Infant wide-field fundus photograph:
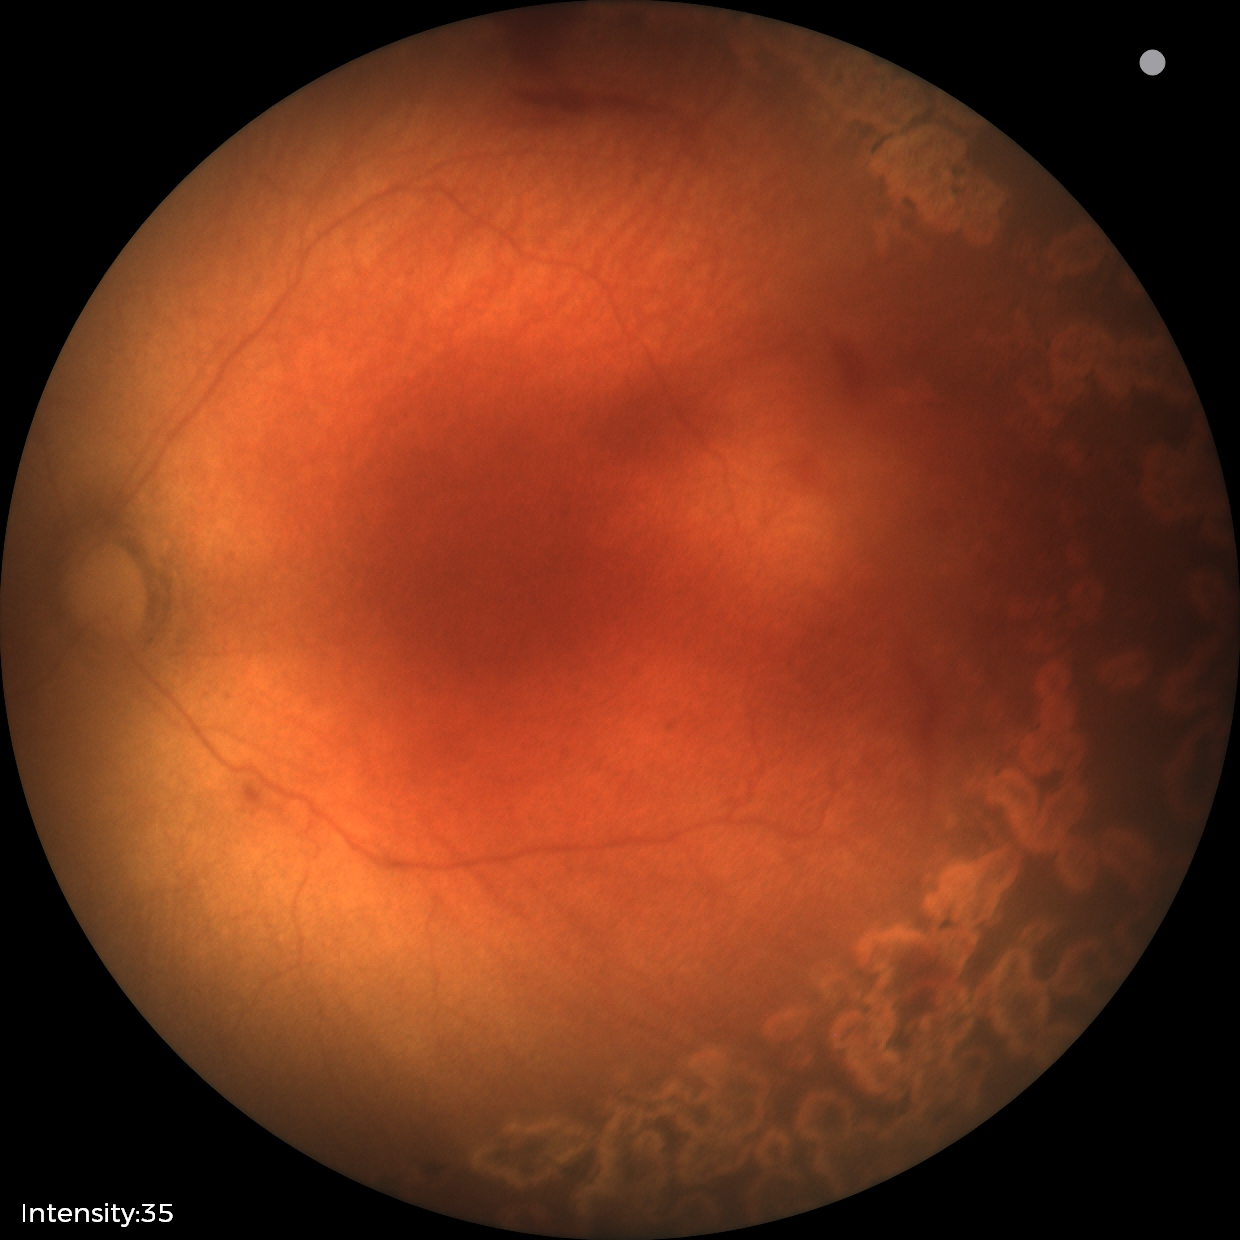

Plus form = absent, assessment = status post ROP.